Modified Davis classification. Retinal fundus photograph. 45-degree field of view
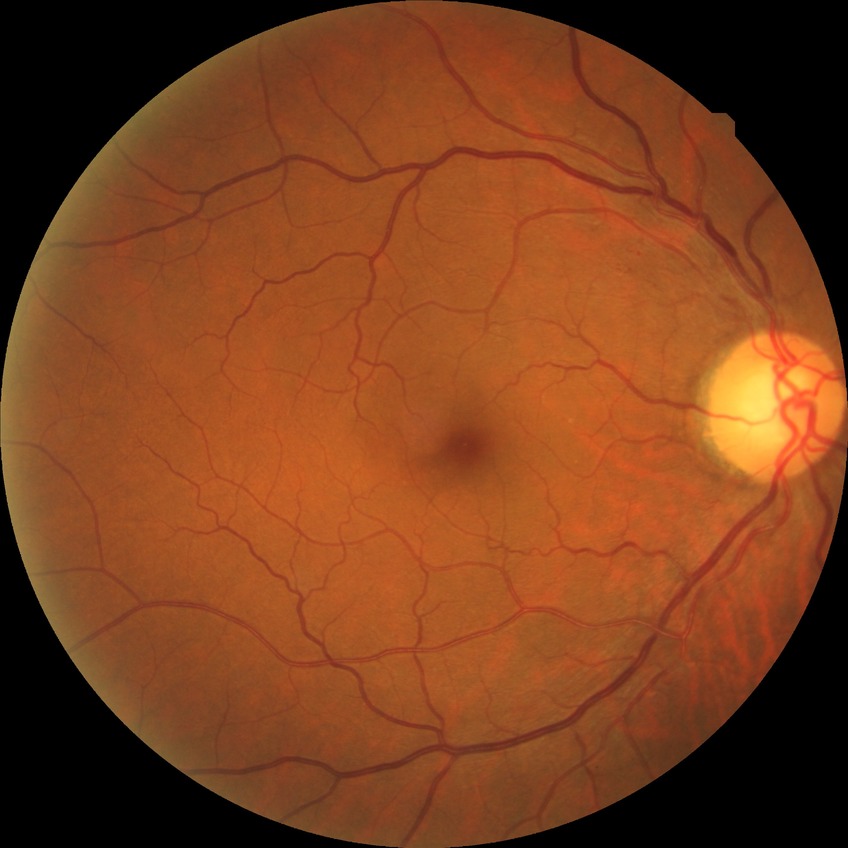

davis_grade: no diabetic retinopathy